Wide-field contact fundus photograph of an infant; captured with the Clarity RetCam 3 (130° field of view) — 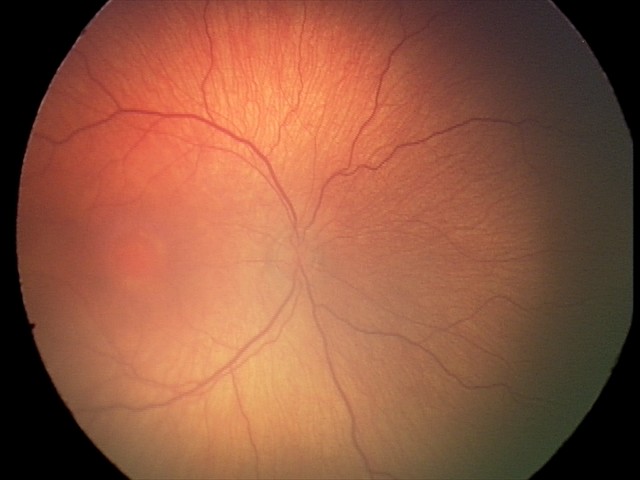 Impression: no plus disease; retinopathy of prematurity stage 2.